Pediatric retinal photograph (wide-field): 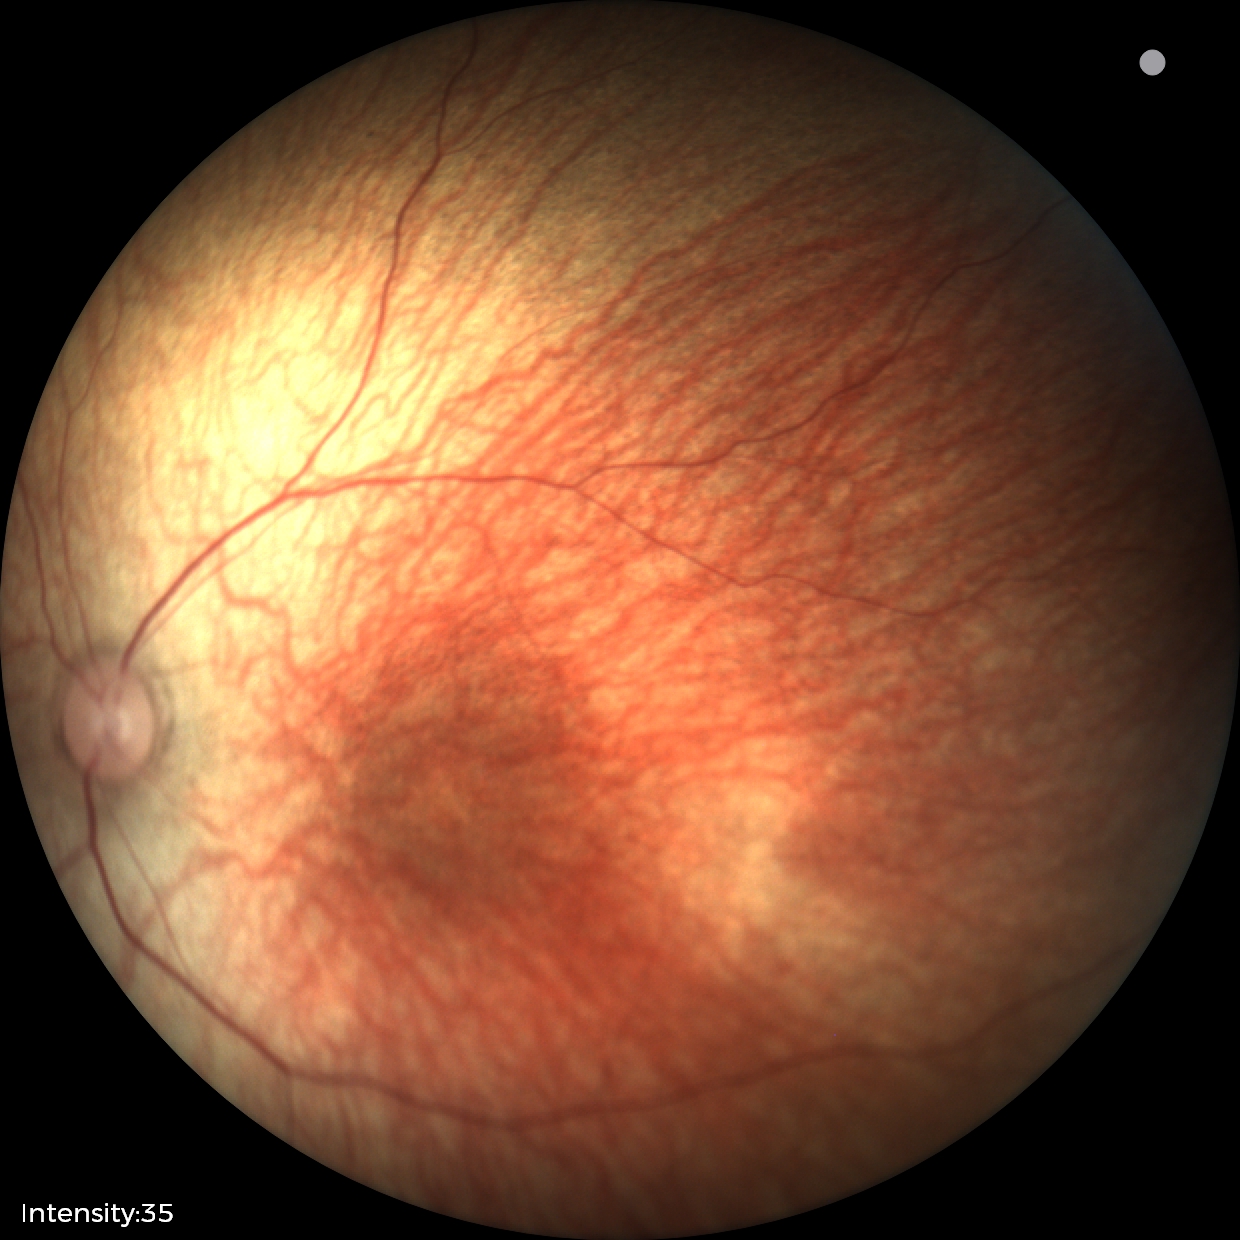
Physiological retinal appearance for postconceptual age.